Image size 640x480 · camera: Clarity RetCam 3 (130° FOV) · wide-field fundus image from infant ROP screening: 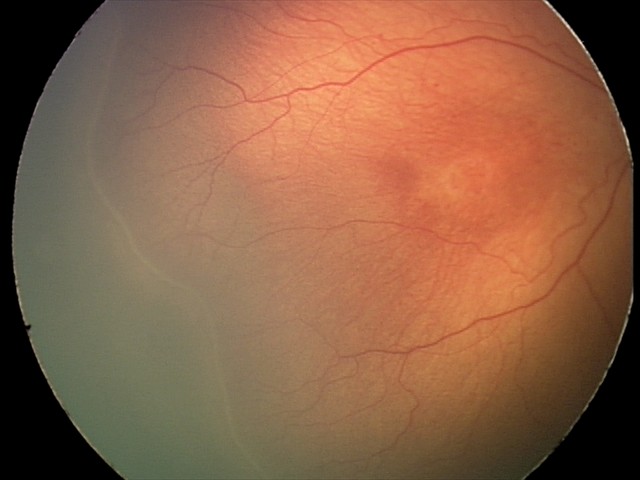 Plus disease absent. Screening examination consistent with ROP stage 2.